Non-mydriatic. Axial length: 23.86 mm. Intraocular pressure 17 mmHg. 2212x1661.
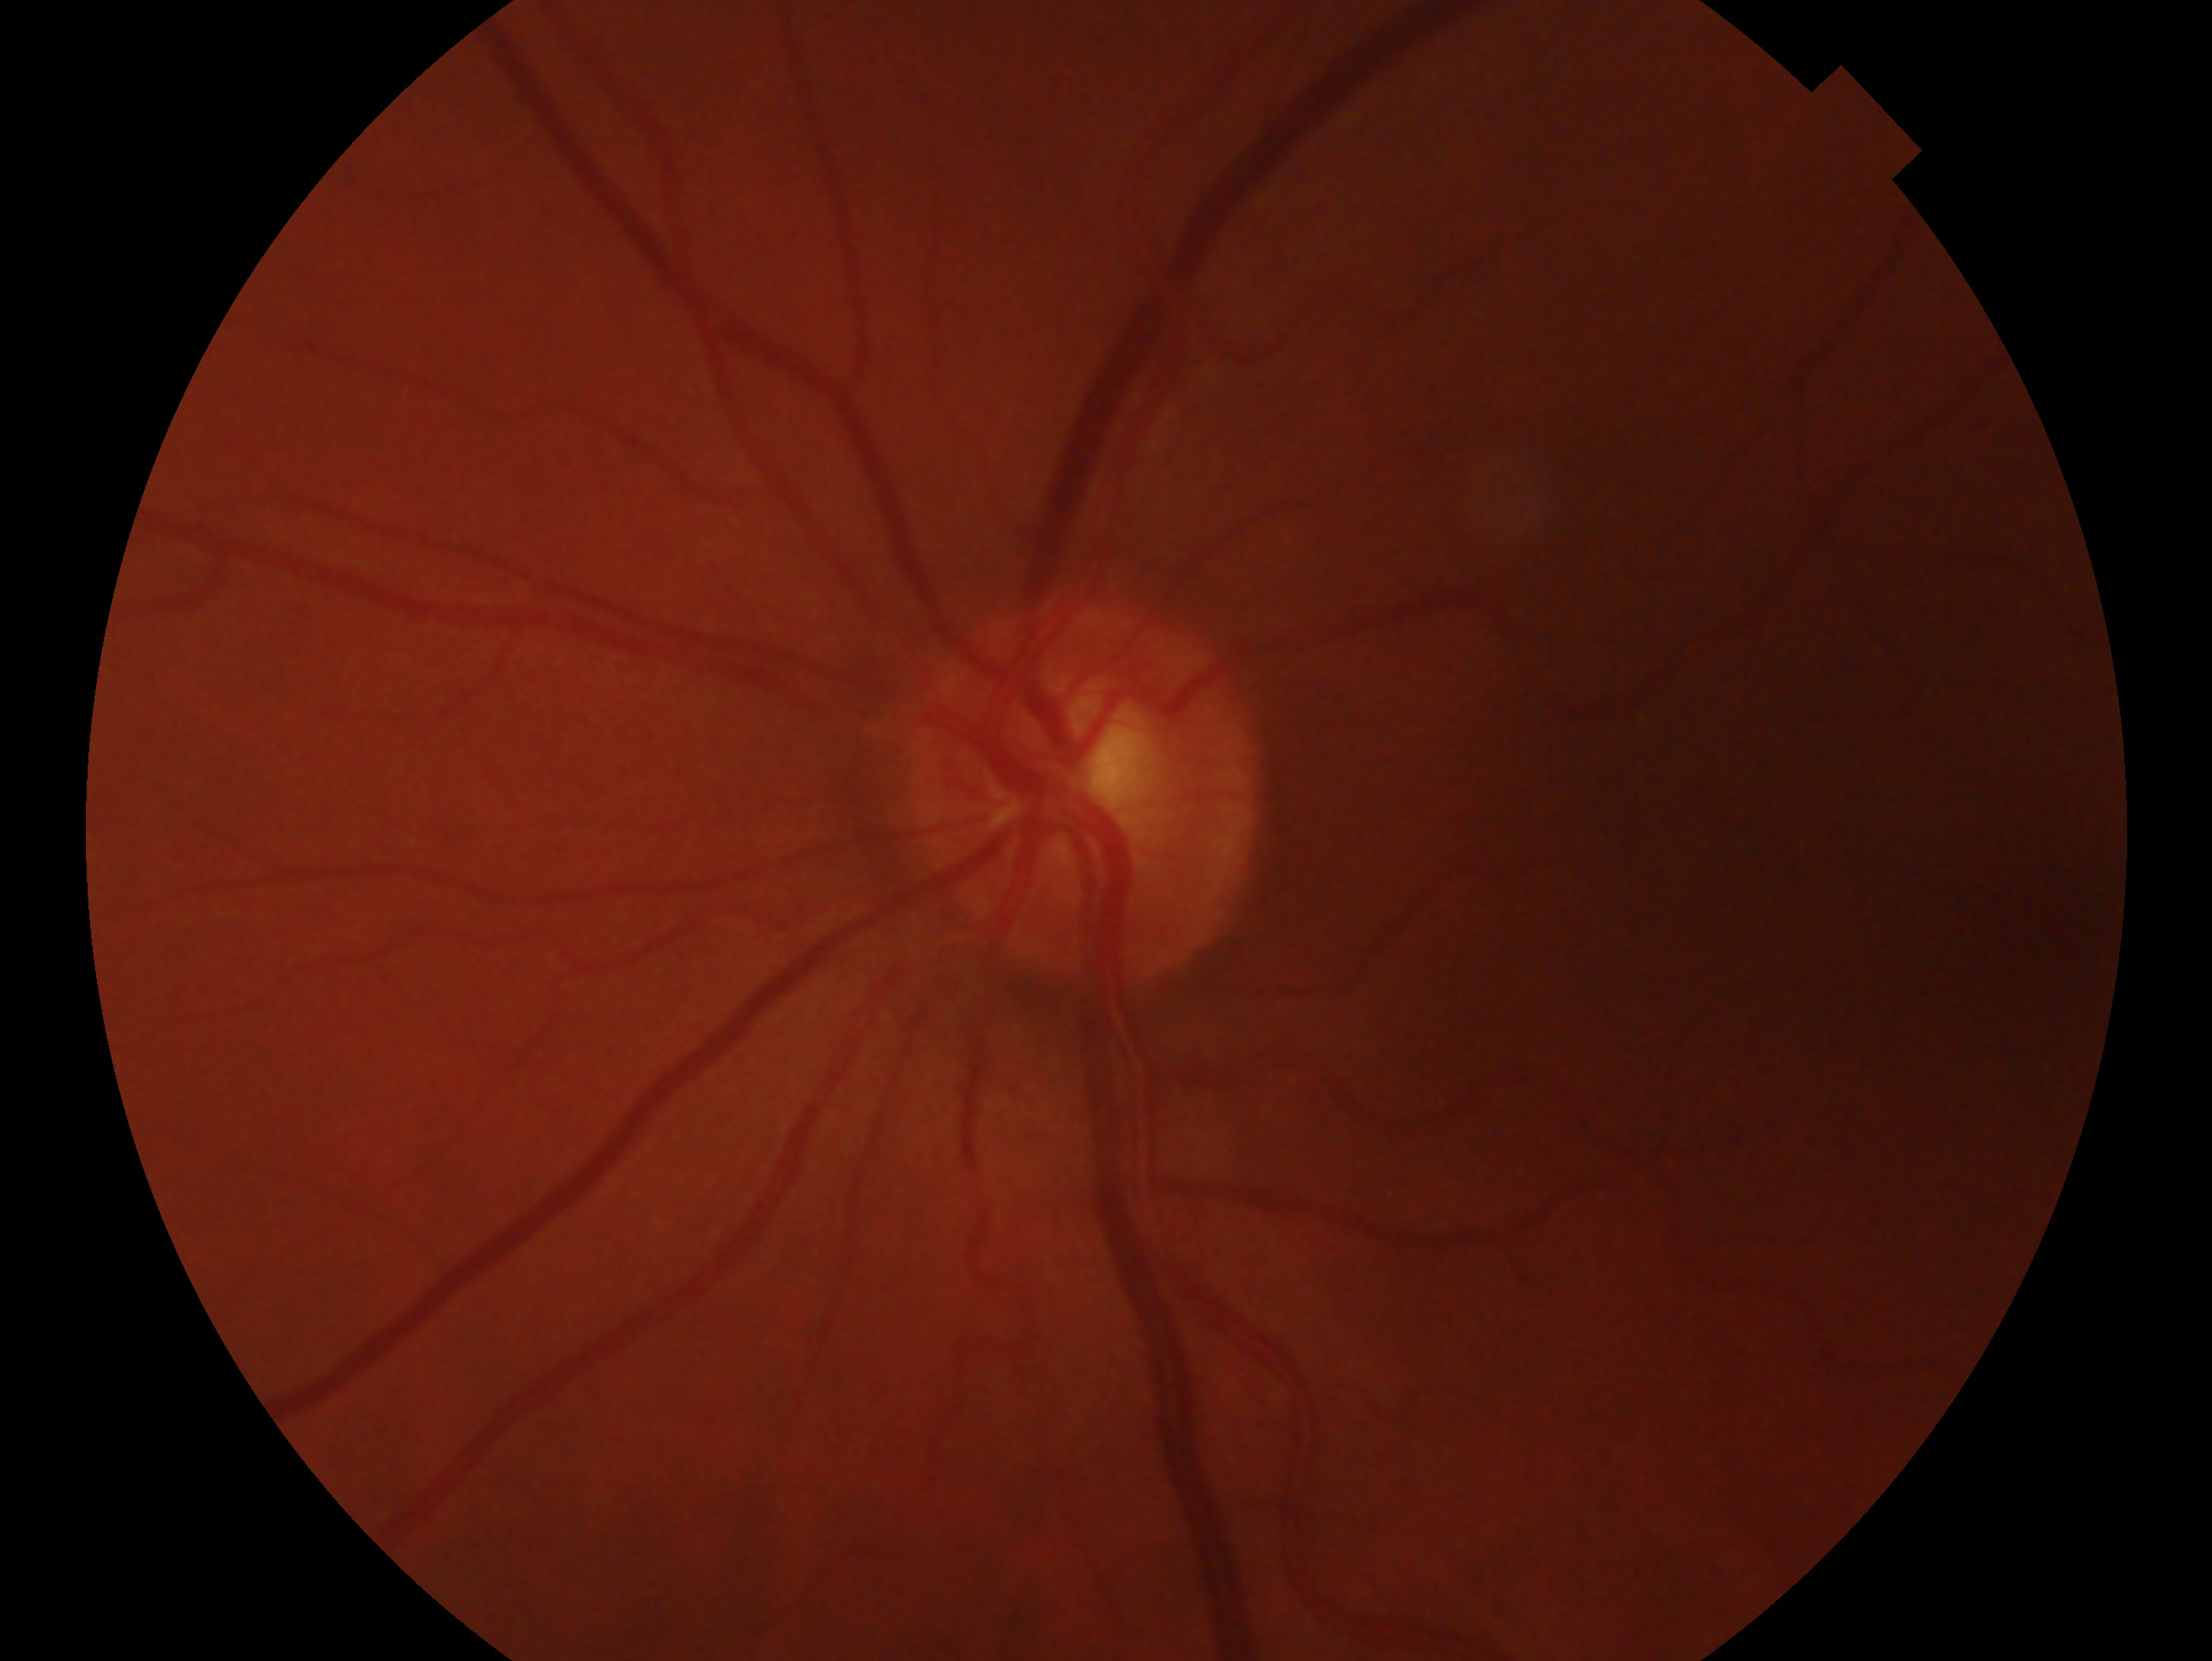
Annotations:
- impression — glaucoma — clinically confirmed glaucoma with characteristic optic nerve damage
- eye — OS